Modified Davis classification: 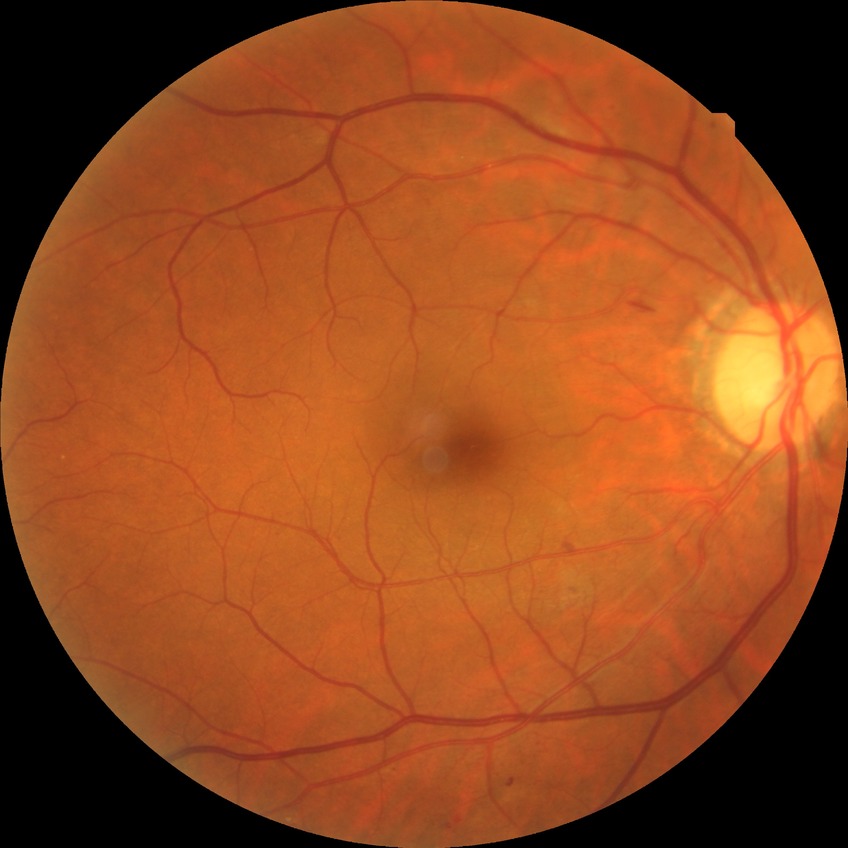

Retinopathy stage: simple diabetic retinopathy.